45-degree field of view: 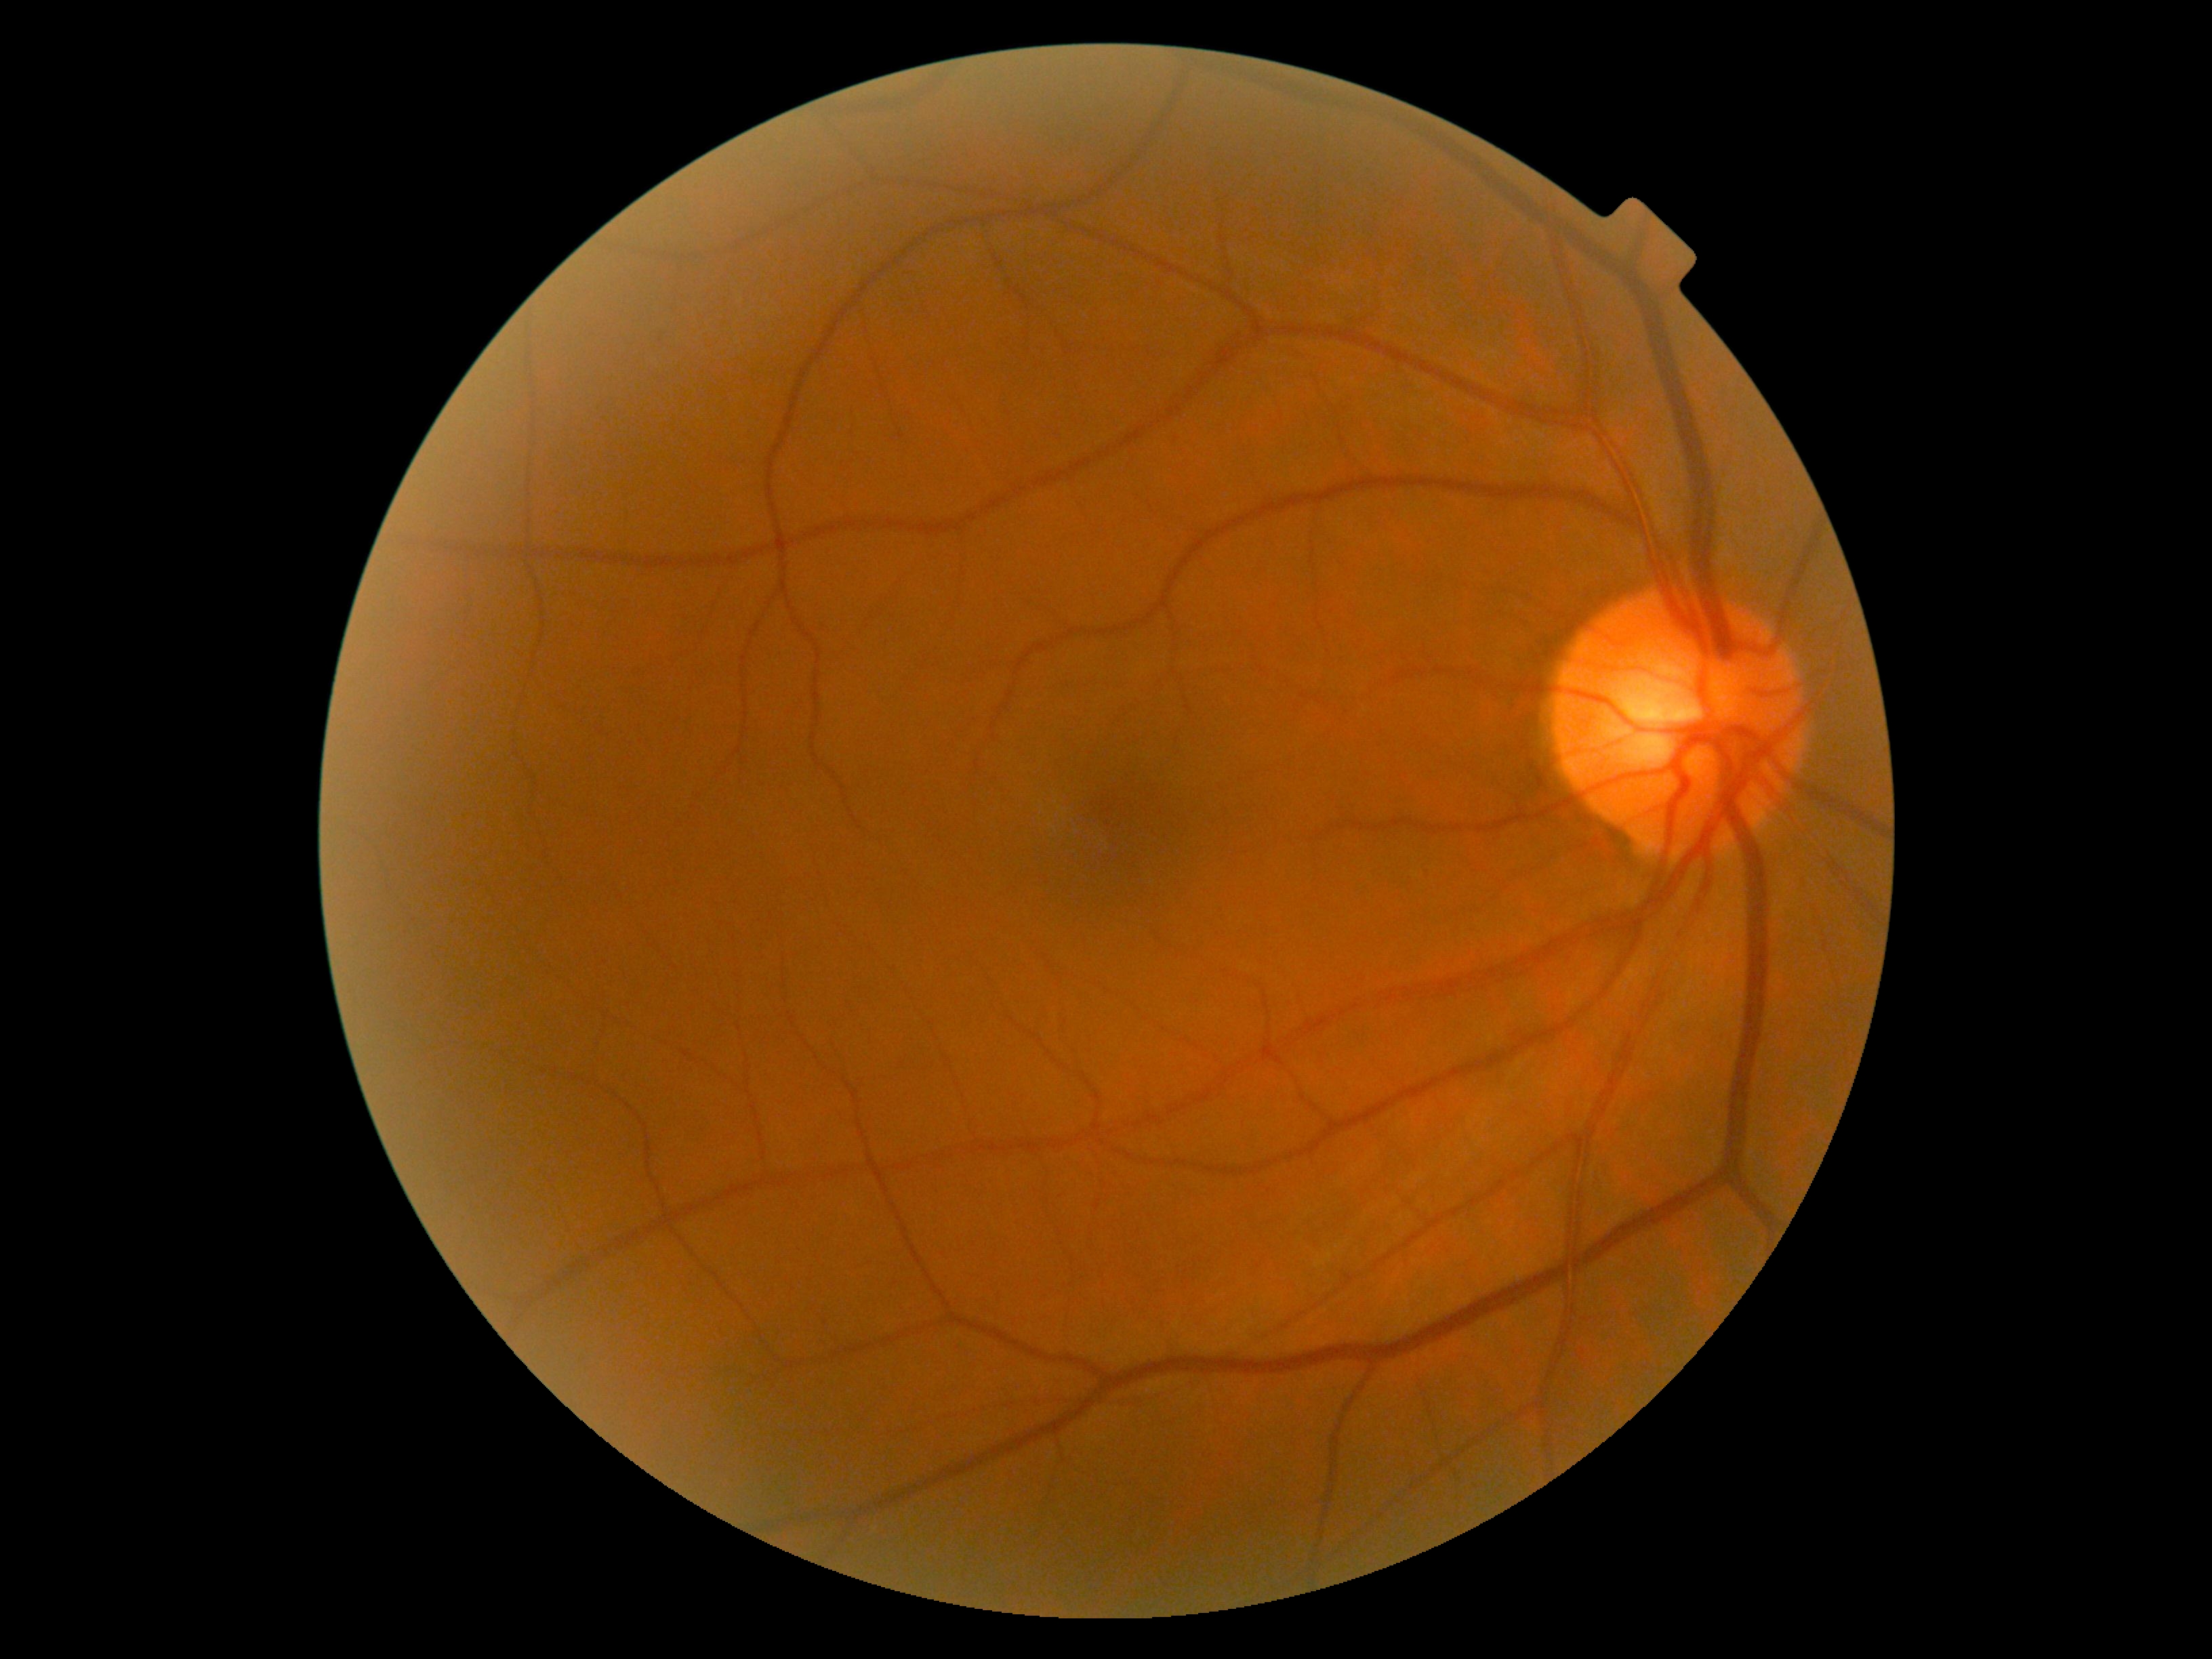
Diabetic retinopathy grade: 0 (no apparent retinopathy).